Pediatric retinal photograph (wide-field); 1240 by 1240 pixels — 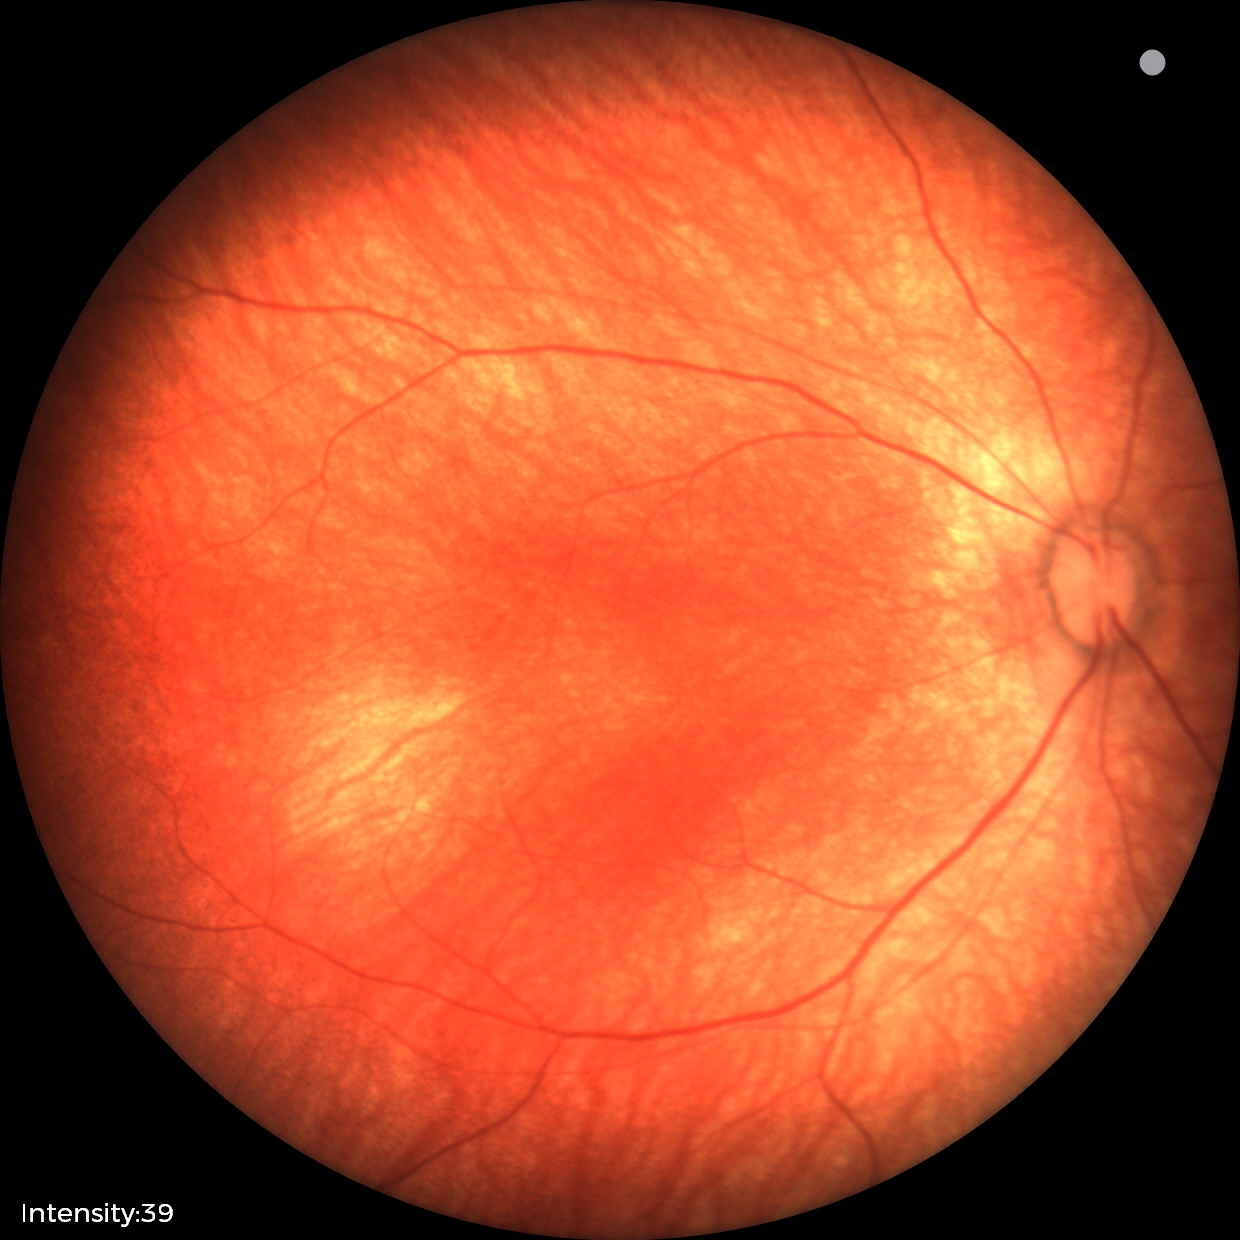
Q: What was the screening finding?
A: no abnormal retinal findings